No pharmacologic dilation — 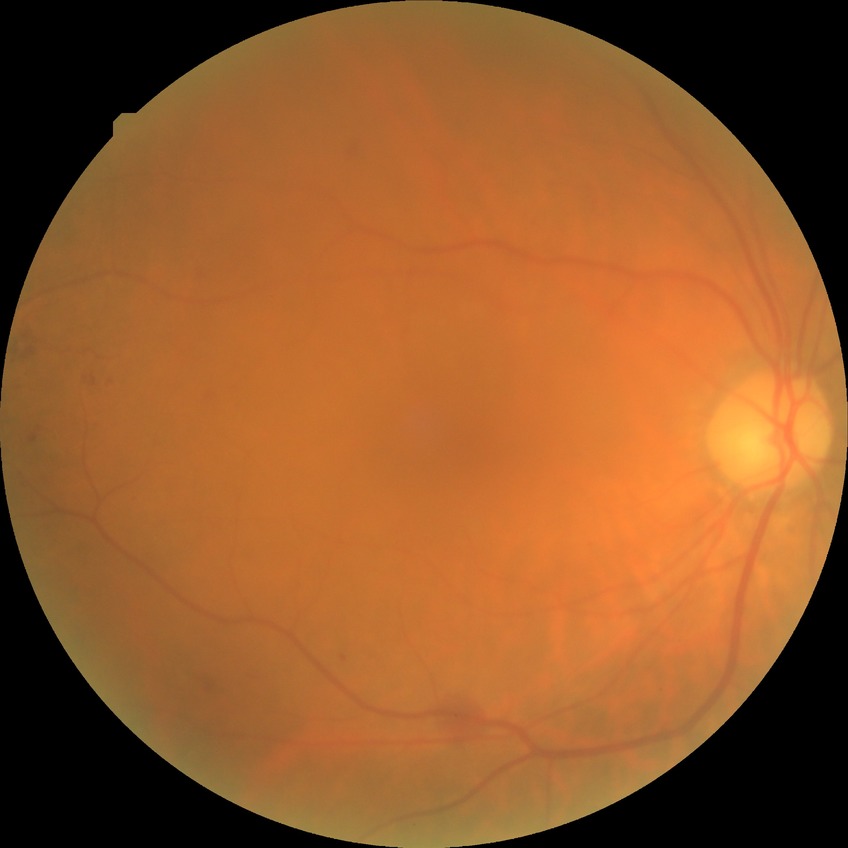
Annotations:
• DR severity: SDR